Infant wide-field fundus photograph; captured with the Clarity RetCam 3 (130° field of view); 640x480 — 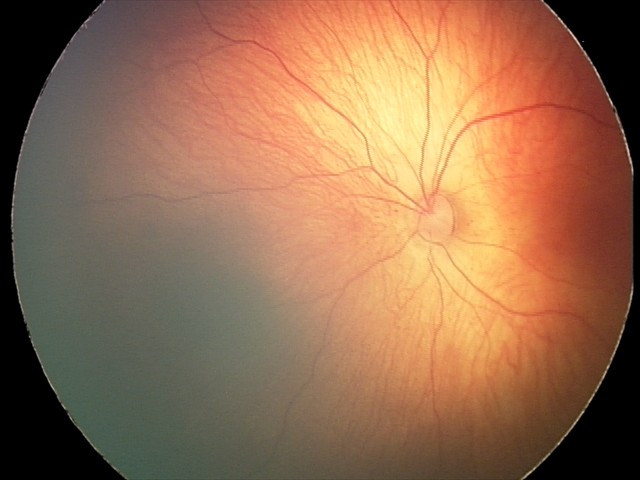

Diagnosis from this screening exam: retinal hemorrhages.